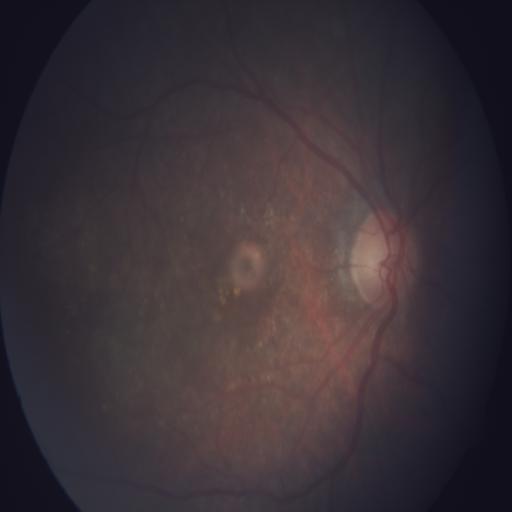

Retinal fundus photograph demonstrating age-related macular degeneration.